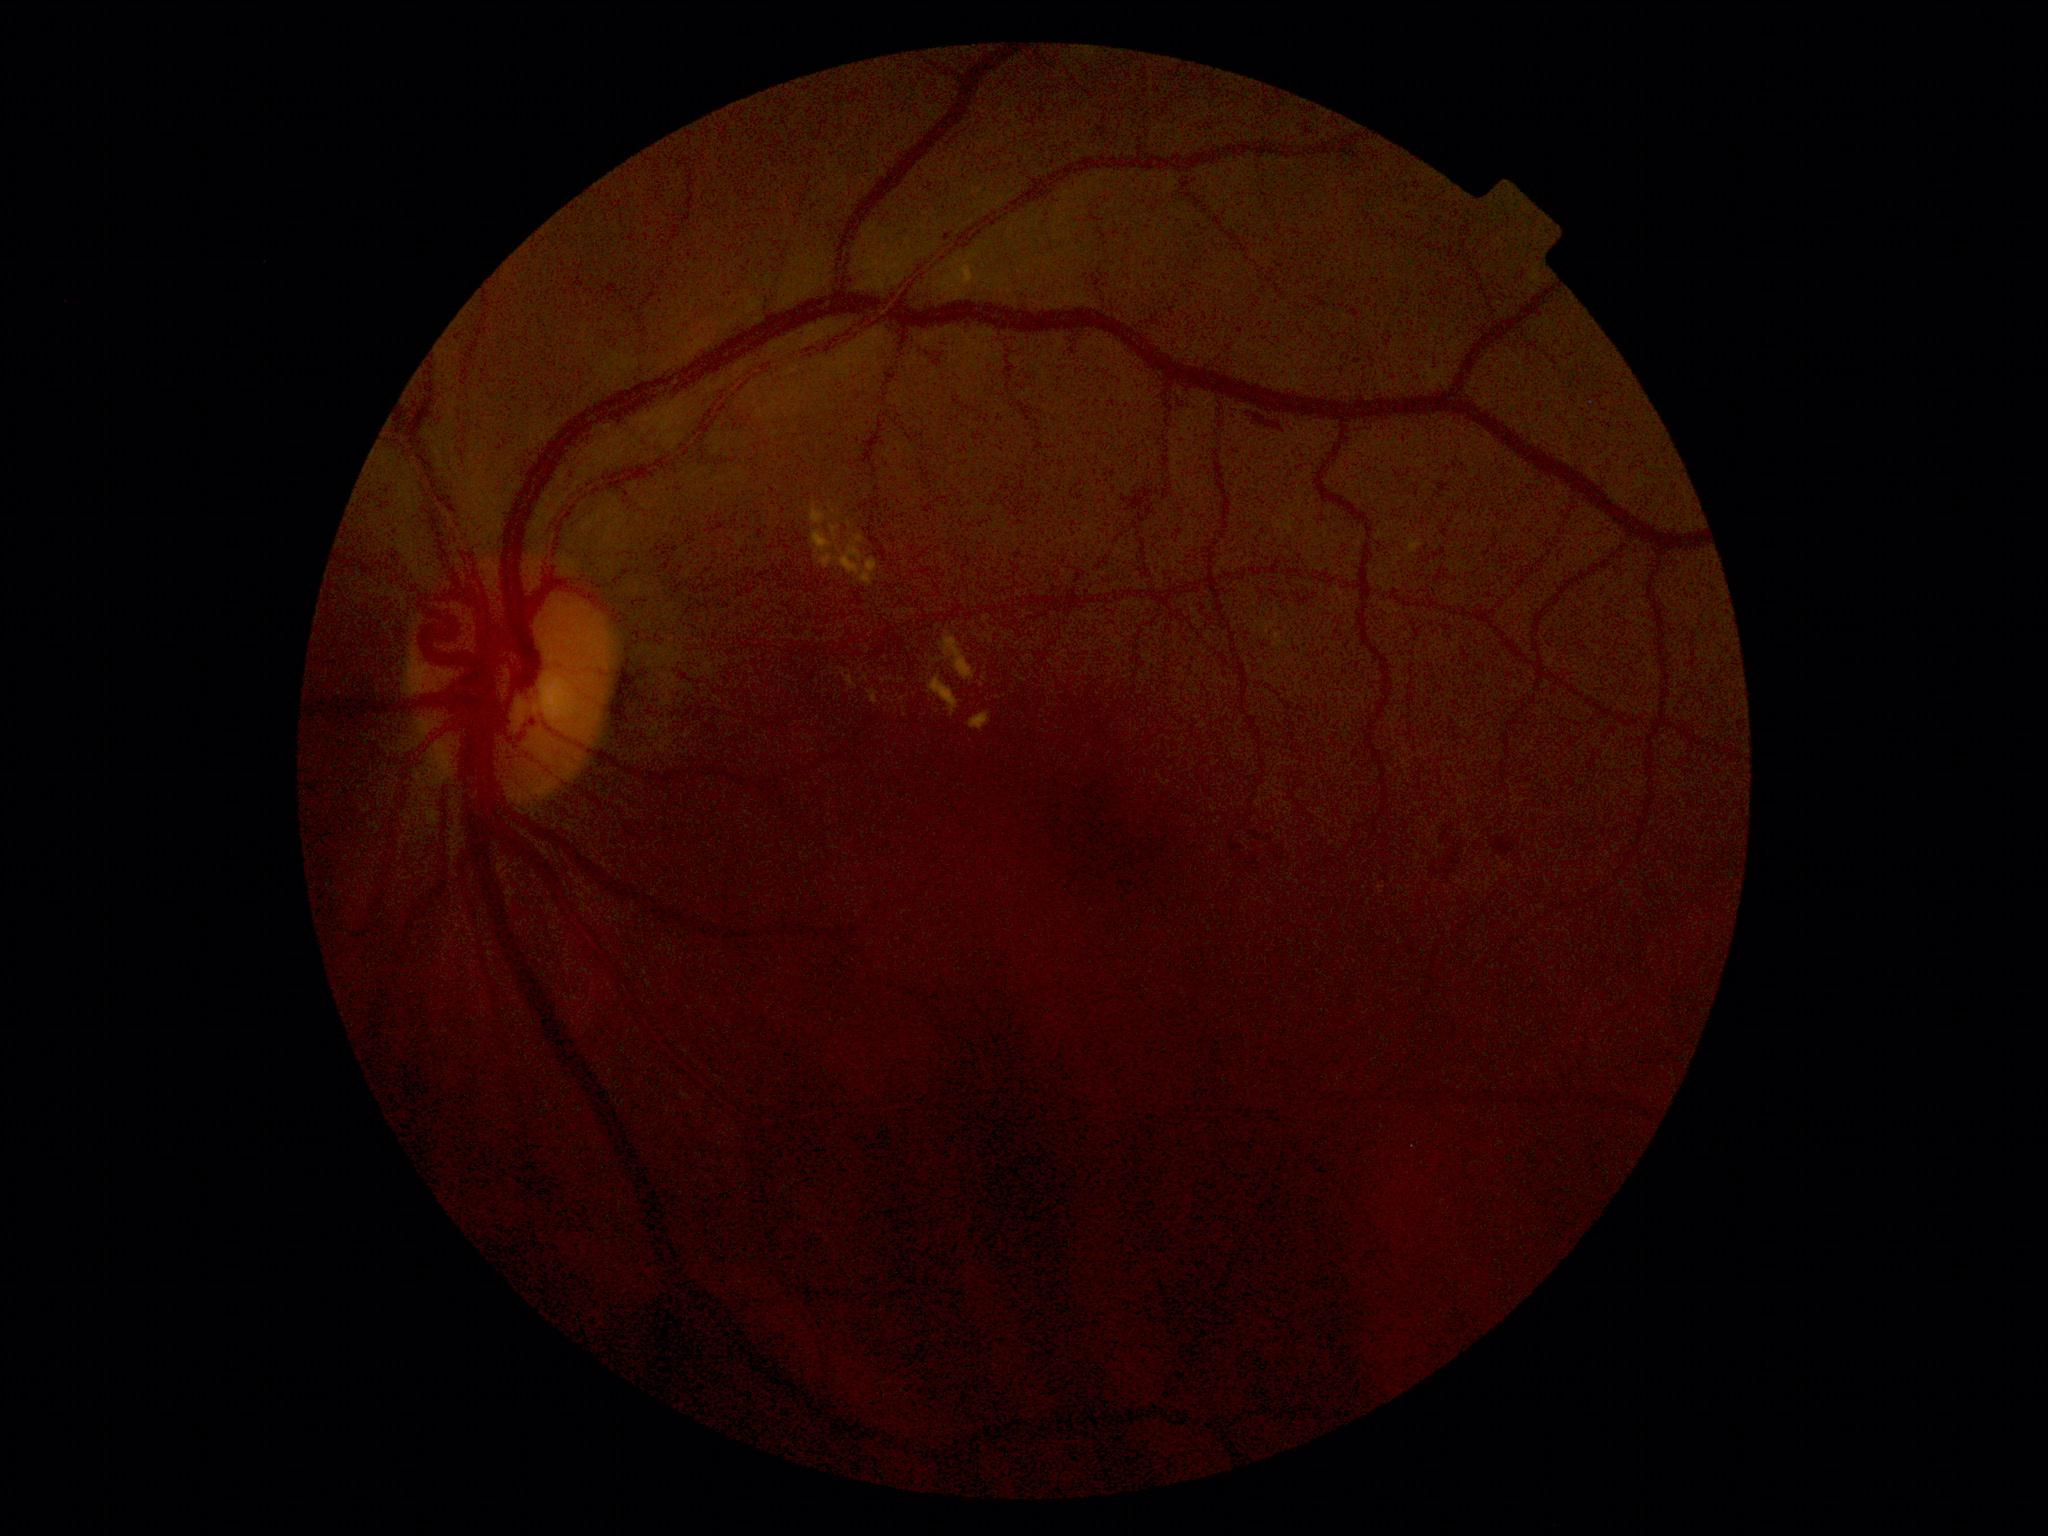
{"dr_grade": "2"}